848x848px. DR severity per modified Davis staging. No pharmacologic dilation: 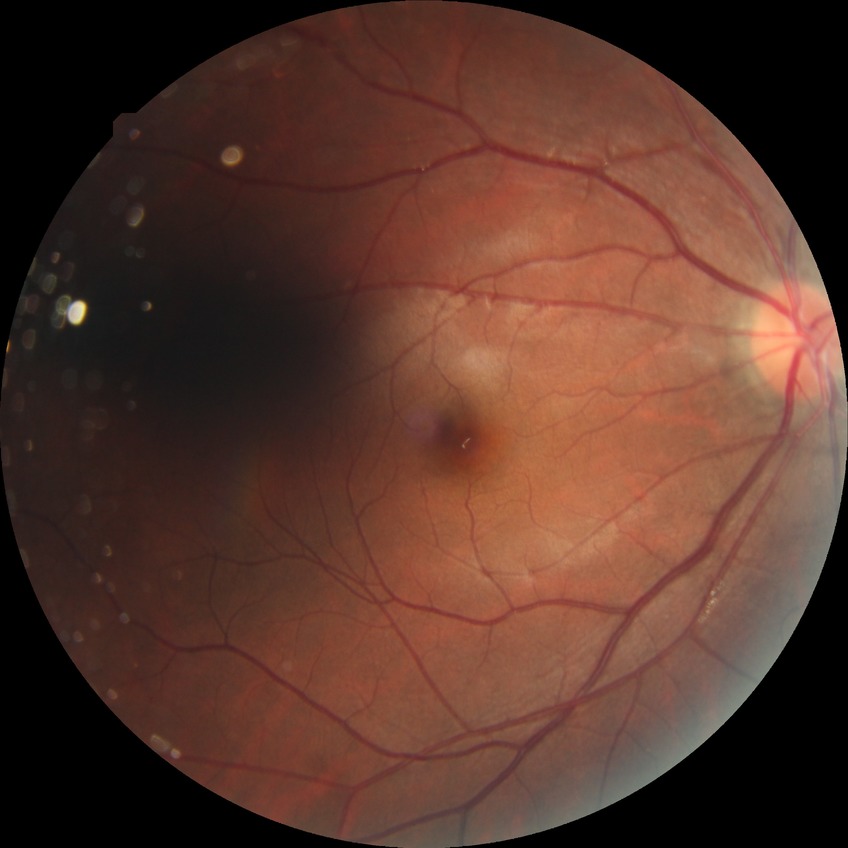

Diabetic retinopathy (DR): NDR (no diabetic retinopathy).